45 degree fundus photograph, graded on the modified Davis scale, nonmydriatic, NIDEK AFC-230 fundus camera: 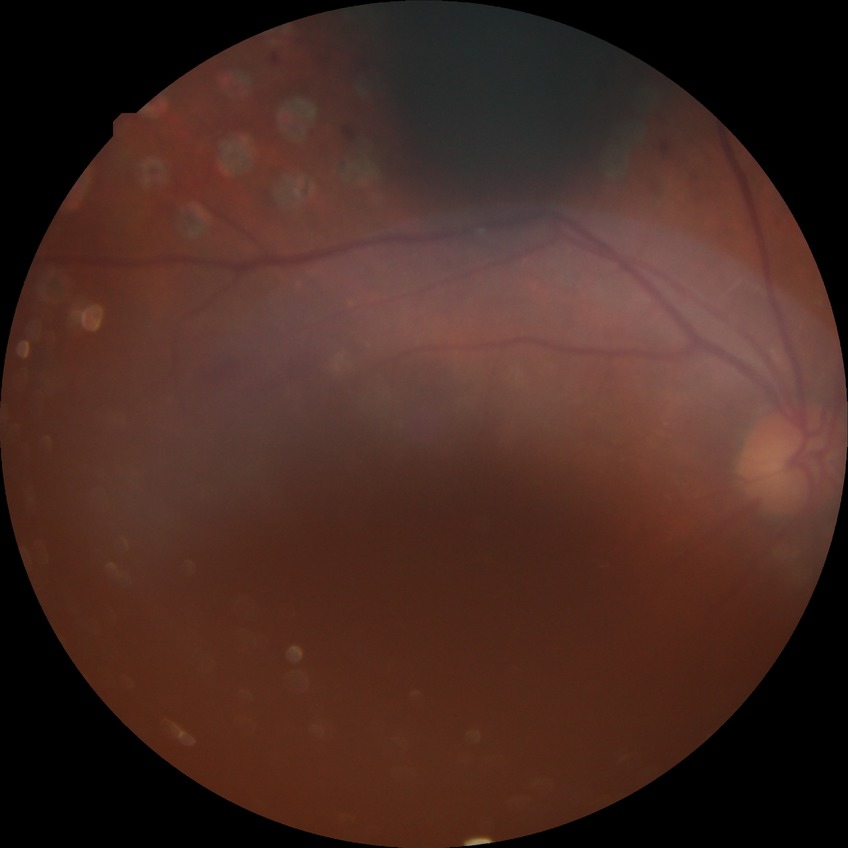

Davis grade is PDR.